Modified Davis classification · NIDEK AFC-230:
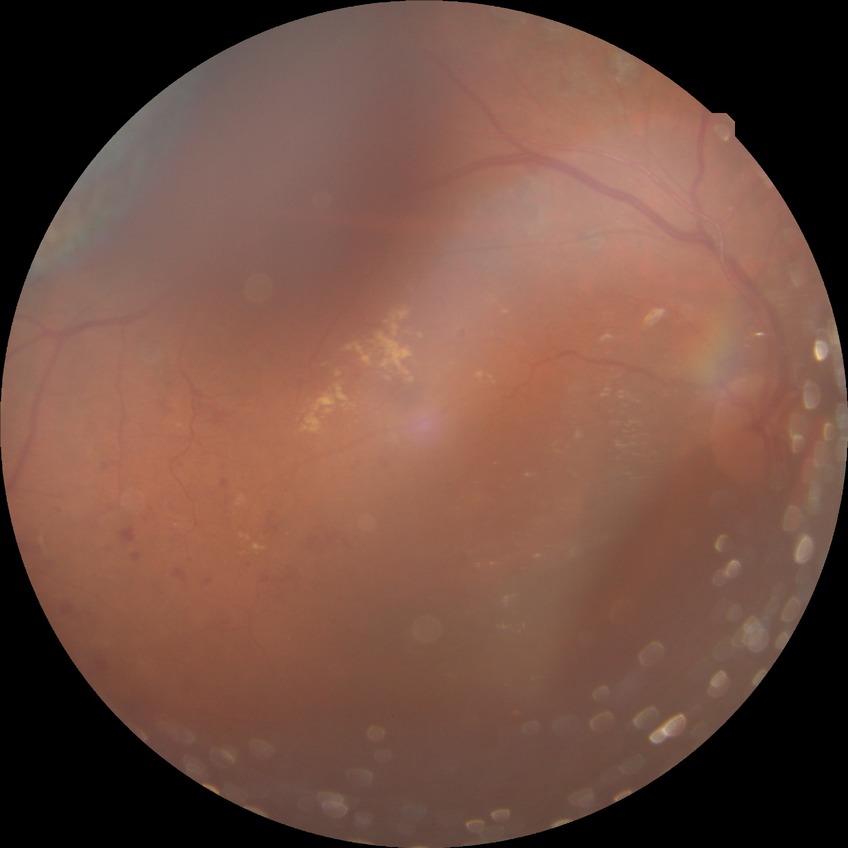 Diabetic retinopathy severity is proliferative diabetic retinopathy.